2048 by 1536 pixels.
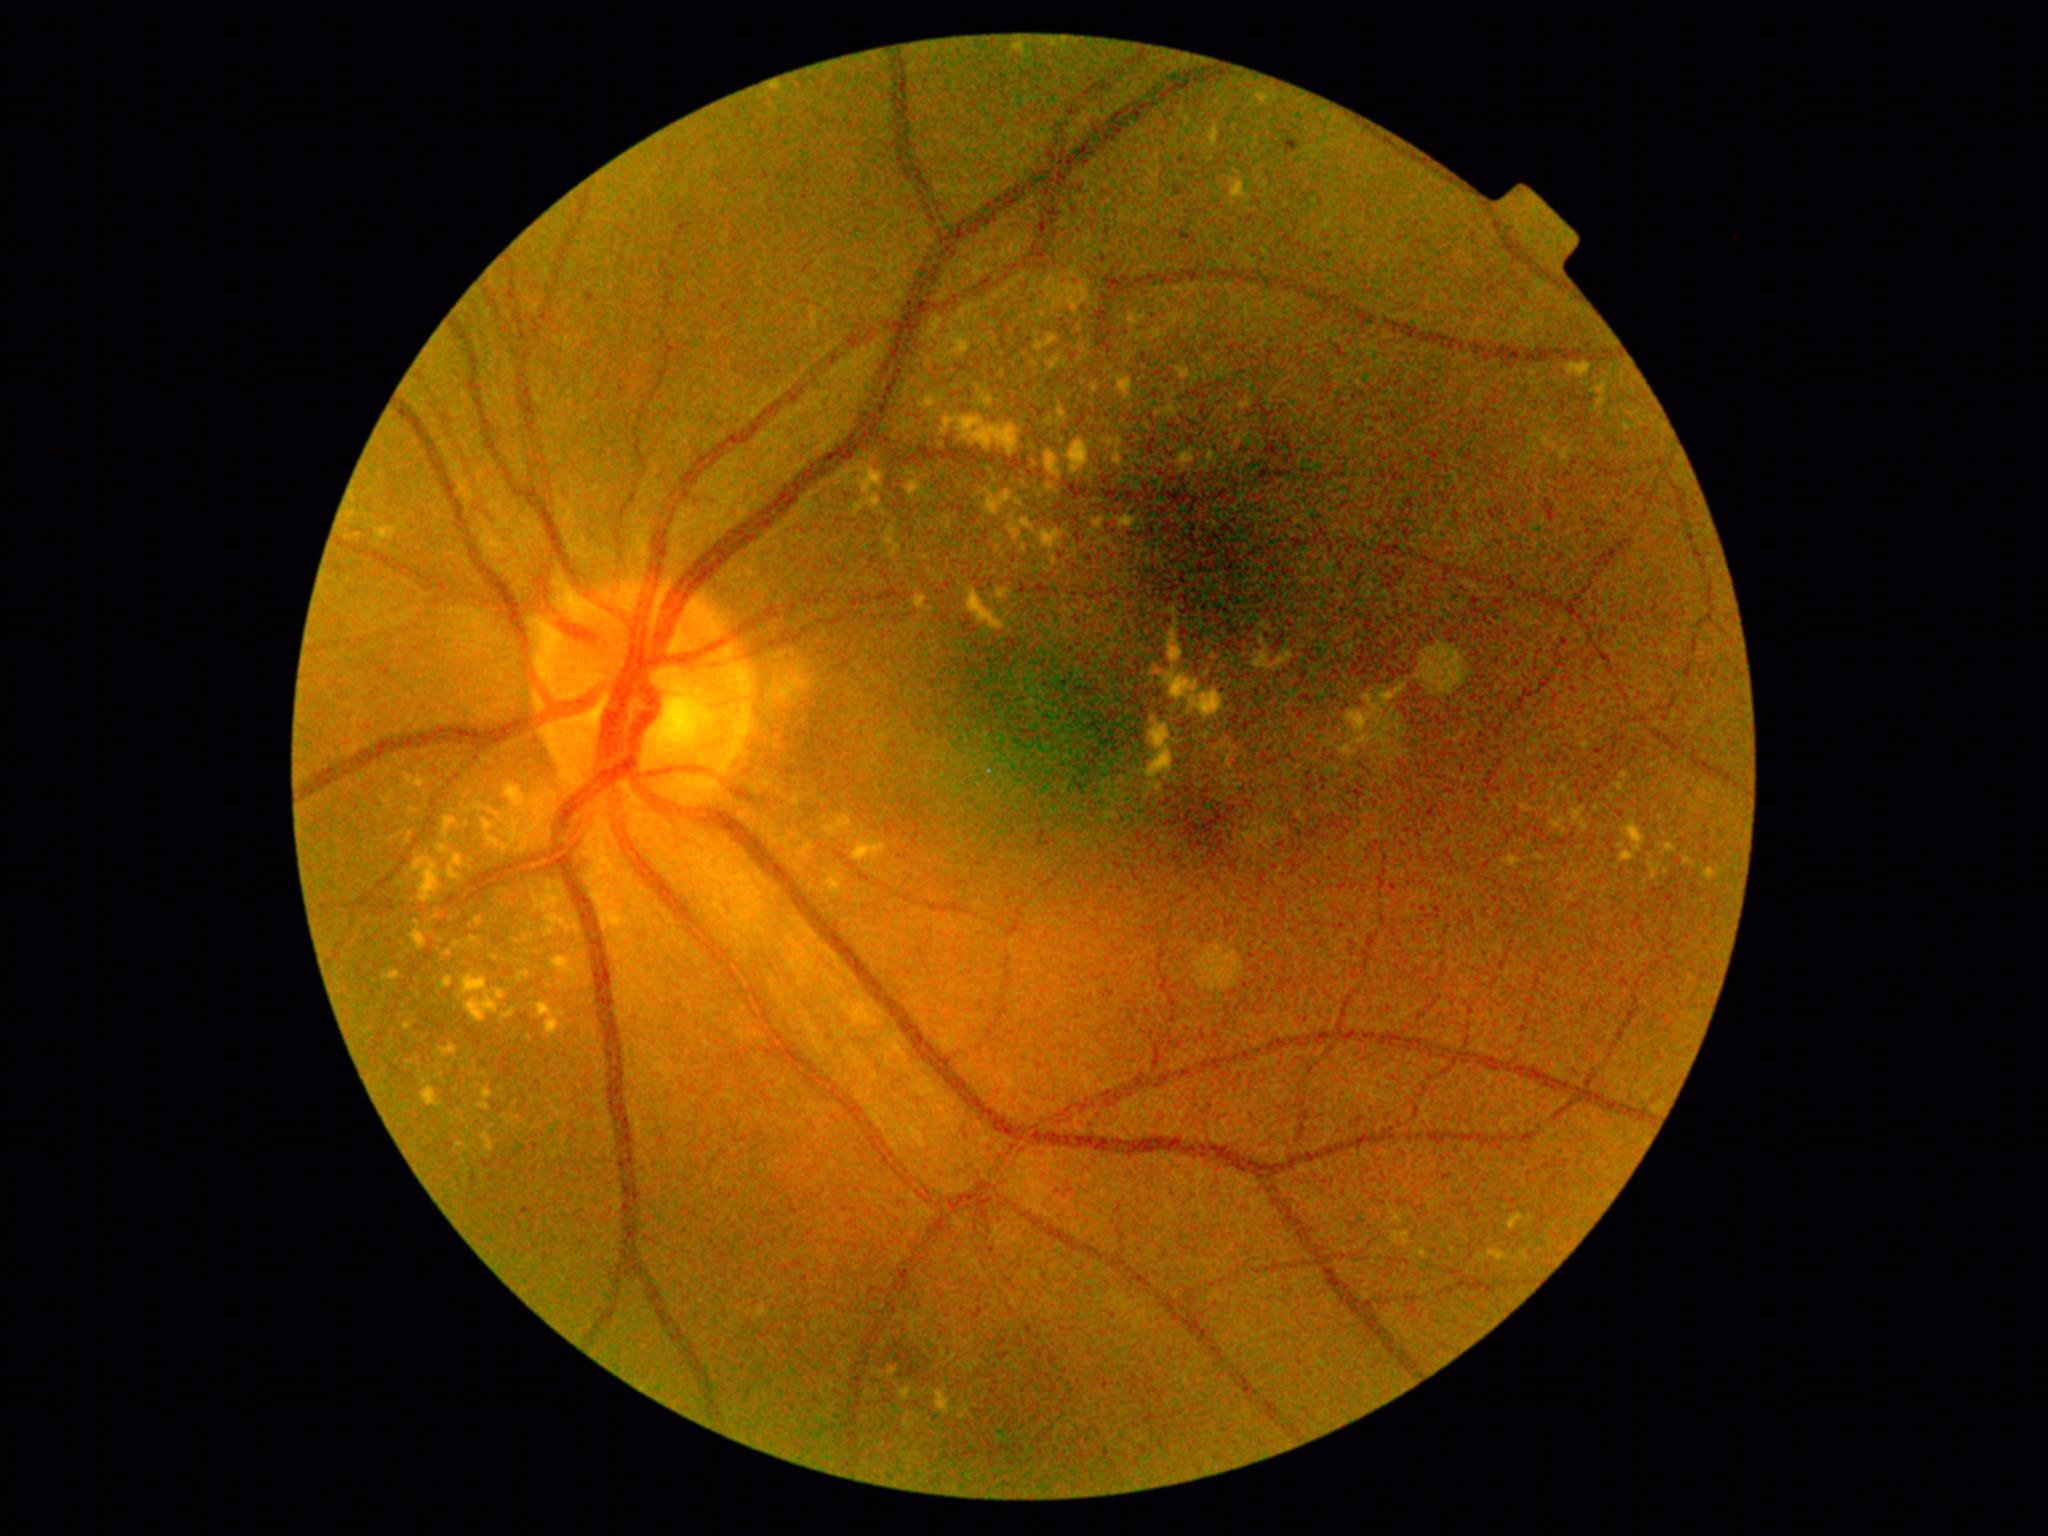

<lesions partial="true">
  <dr_grade>2</dr_grade>
  <ex partial="true">(1573,807,1586,822) | (496,991,504,1000) | (464,976,487,994) | (520,973,530,978) | (838,818,851,828) | (1653,867,1661,878) | (489,838,500,847) | (423,1087,437,1106) | (1076,327,1082,335) | (443,977,453,988) | (1543,438,1550,447) | (1166,626,1182,662) | (1143,725,1173,779)</ex>
  <ex_small>(1122,447) | (490,809) | (1602,402) | (764,1313) | (1154,720)</ex_small>
</lesions>